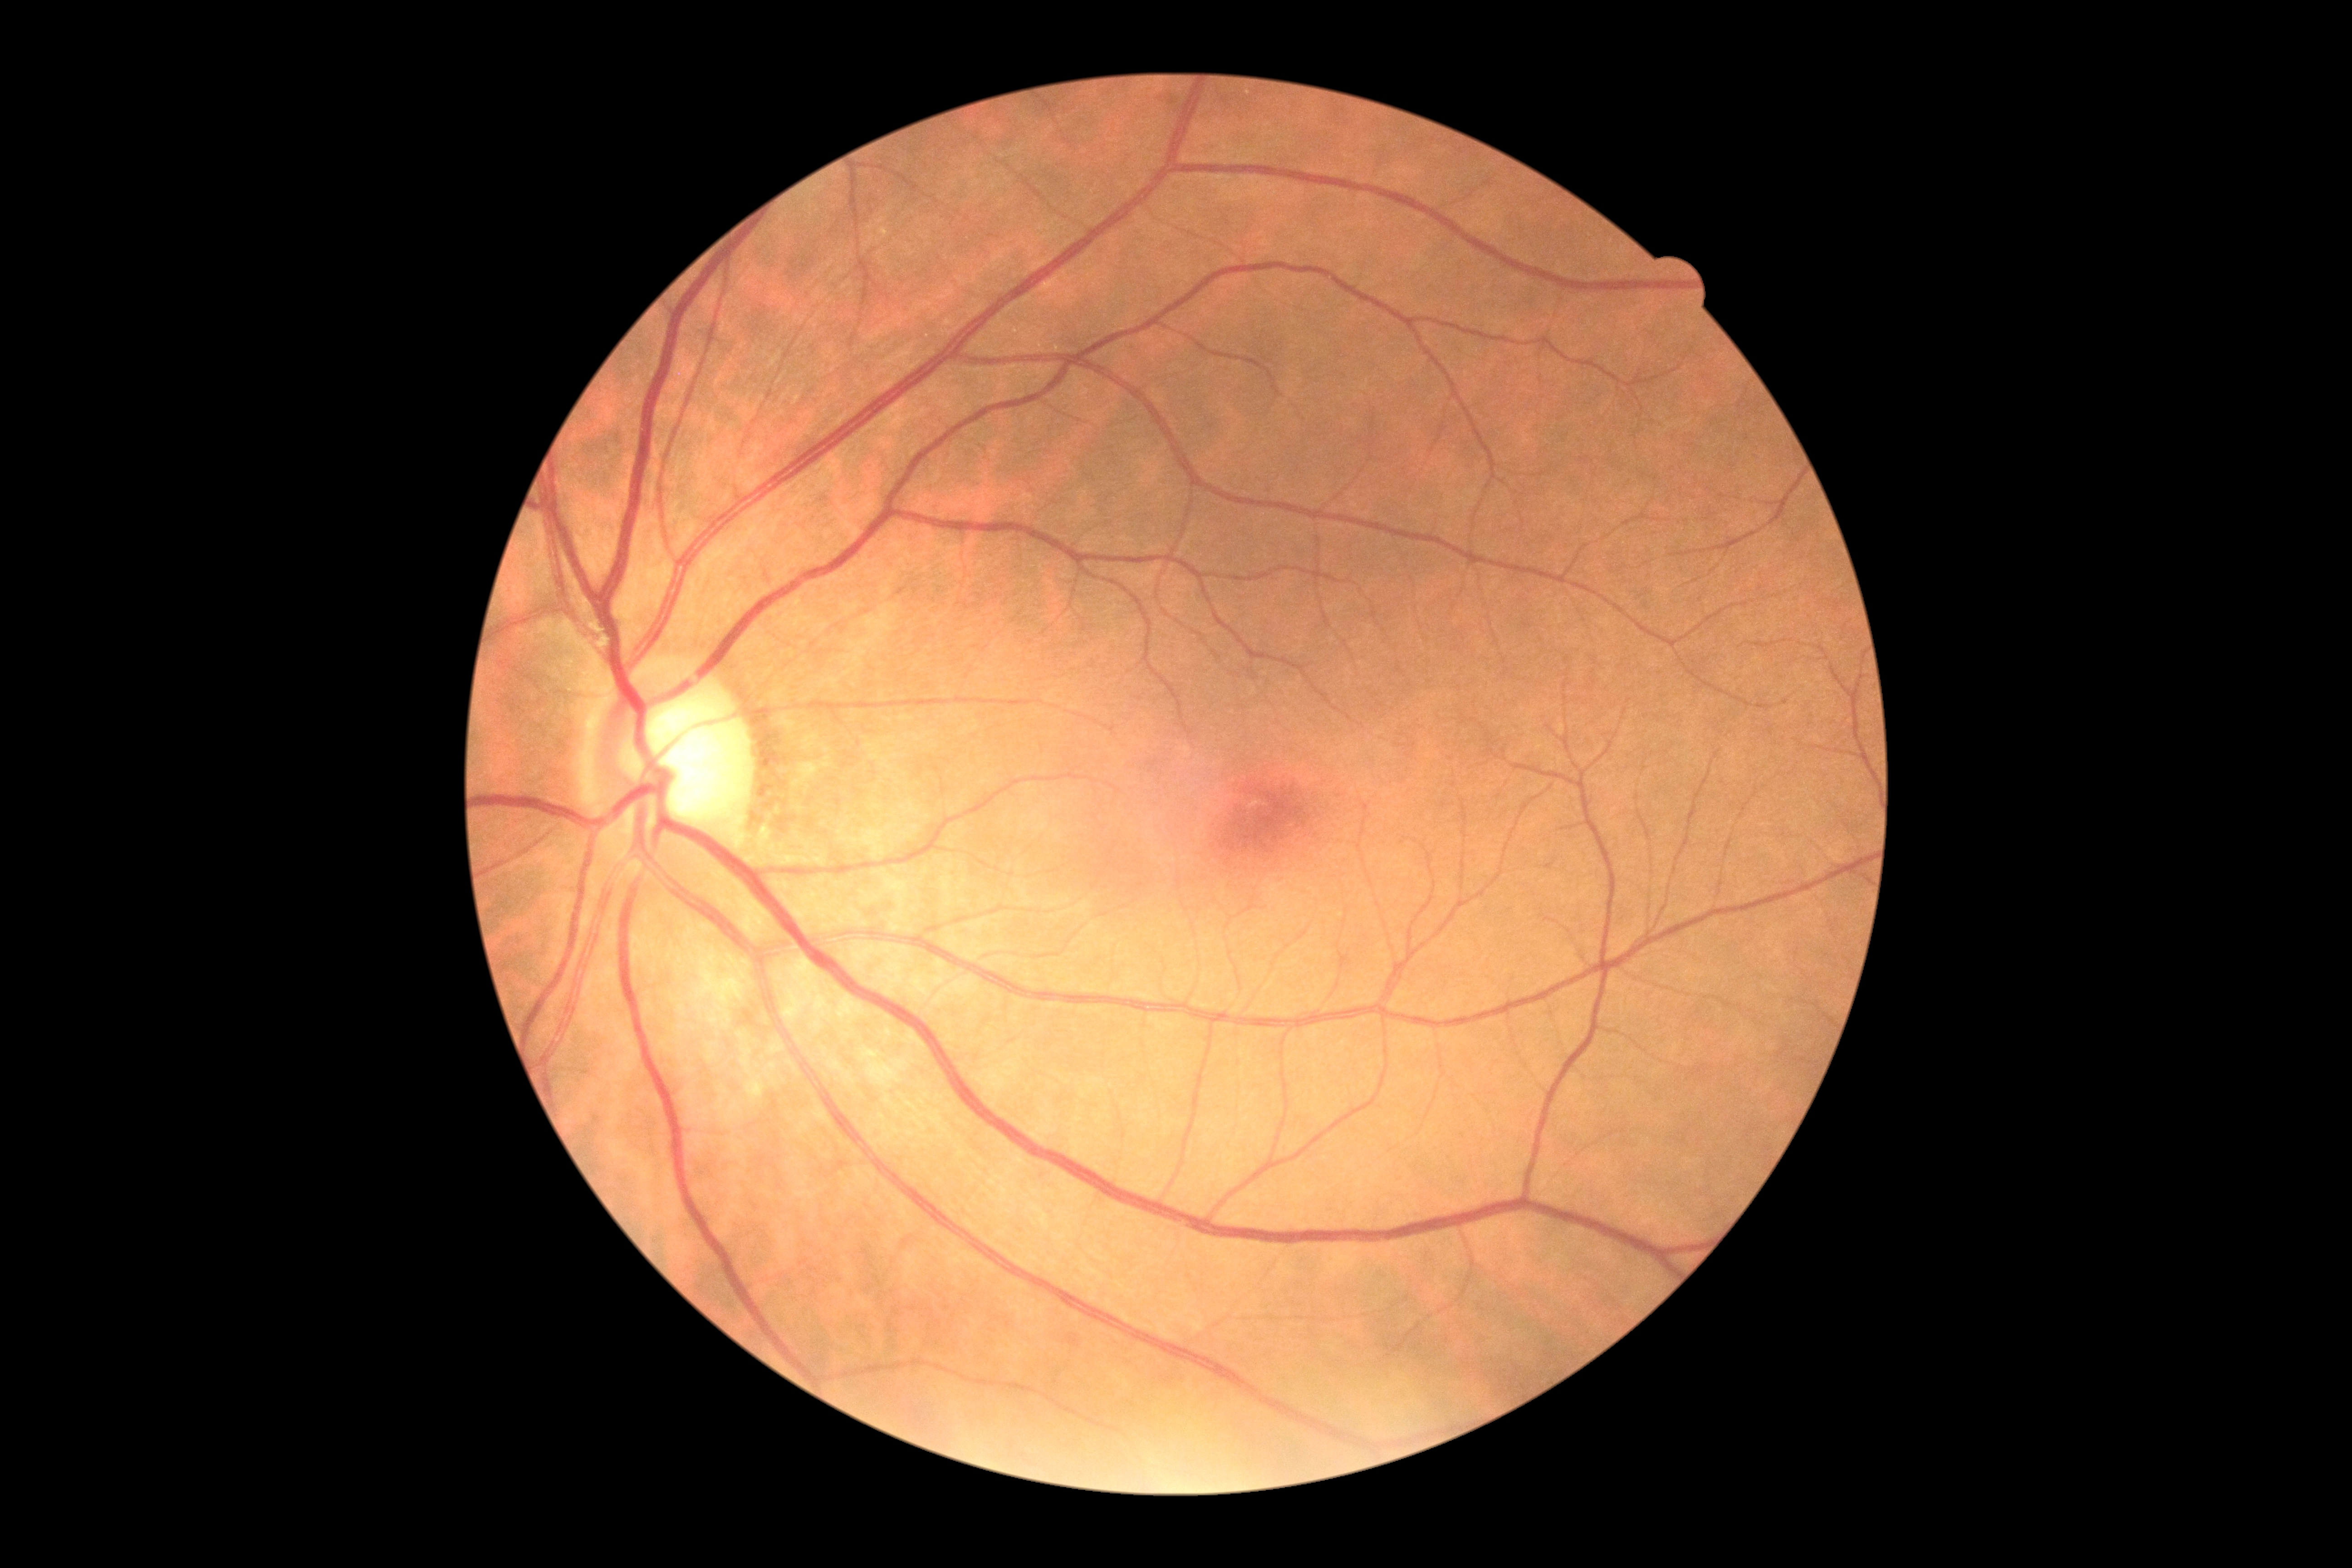
Retinopathy grade is no apparent retinopathy (0) — no visible signs of diabetic retinopathy.
No DR findings.